Color fundus image. 2352x1568. FOV: 45 degrees
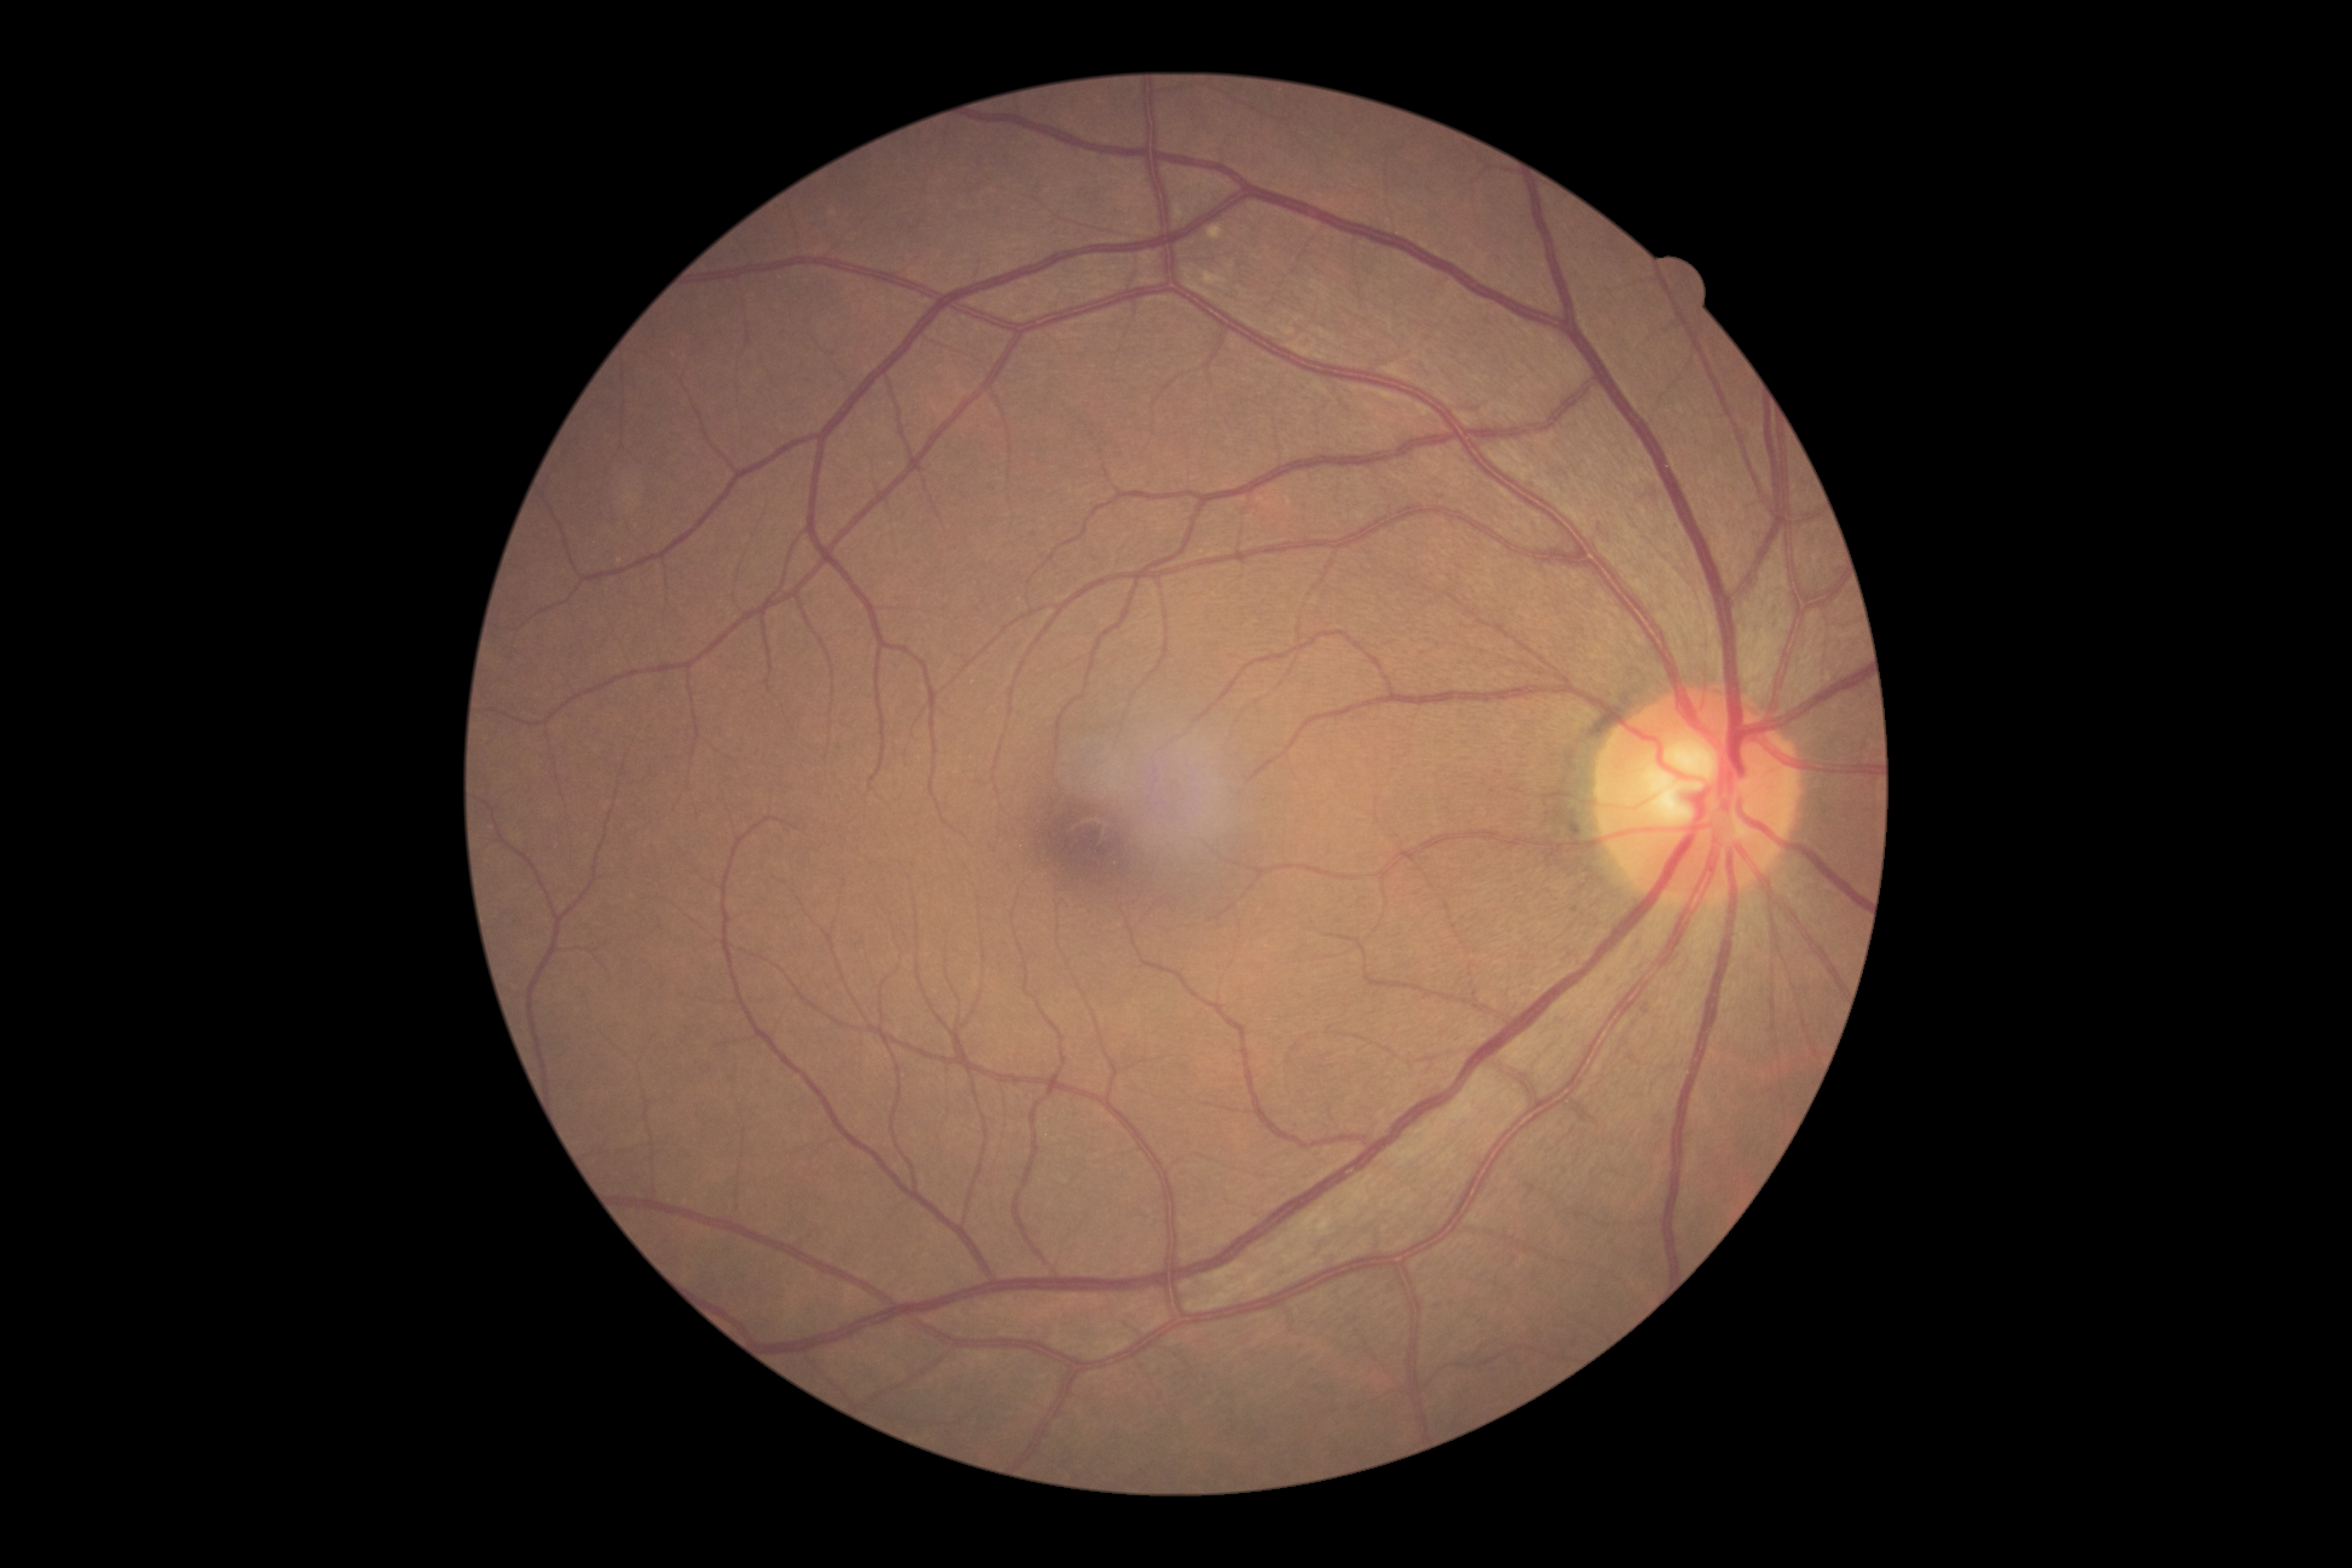

Diabetic retinopathy severity is grade 0 (no apparent retinopathy).